FOV: 45 degrees, image size 848x848, no pharmacologic dilation — 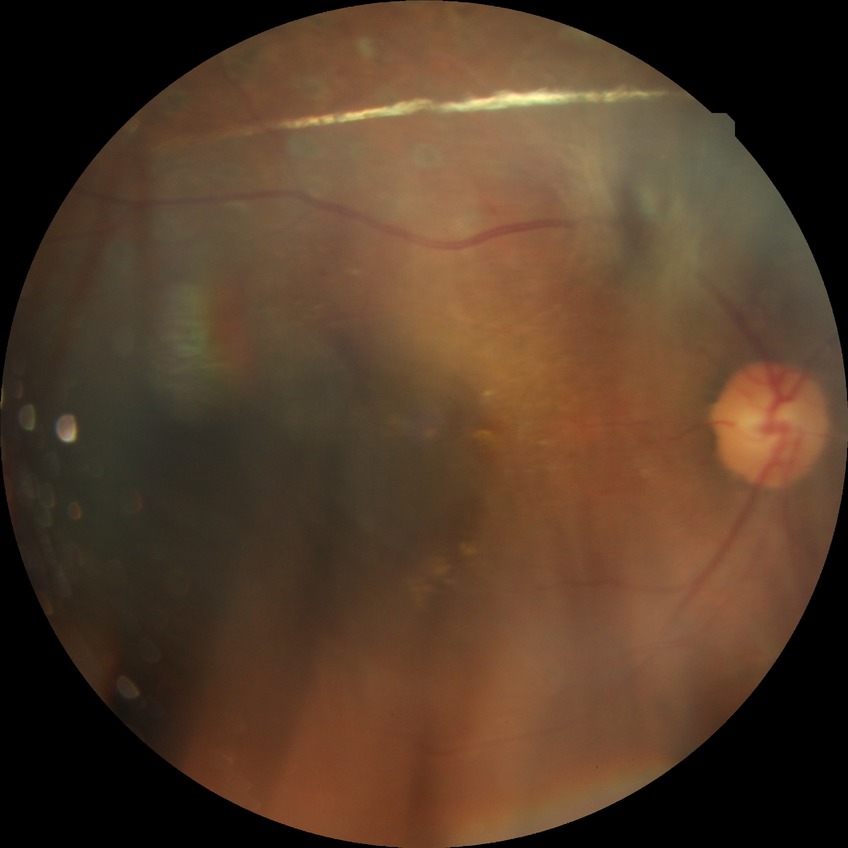

Diabetic retinopathy grade is proliferative diabetic retinopathy.